Posterior pole photograph · camera: NIDEK AFC-230 · without pupil dilation · DR severity per modified Davis staging · 45° FOV:
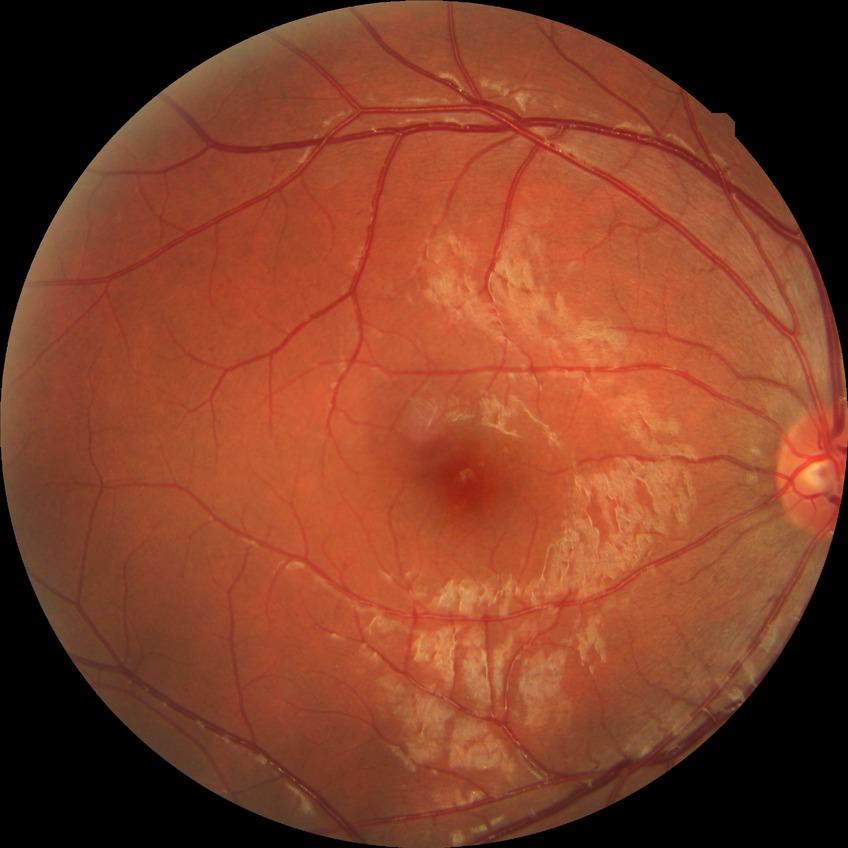

Assessment:
* DR grade: NDR